1240 x 1240 pixels. Pediatric wide-field fundus photograph: 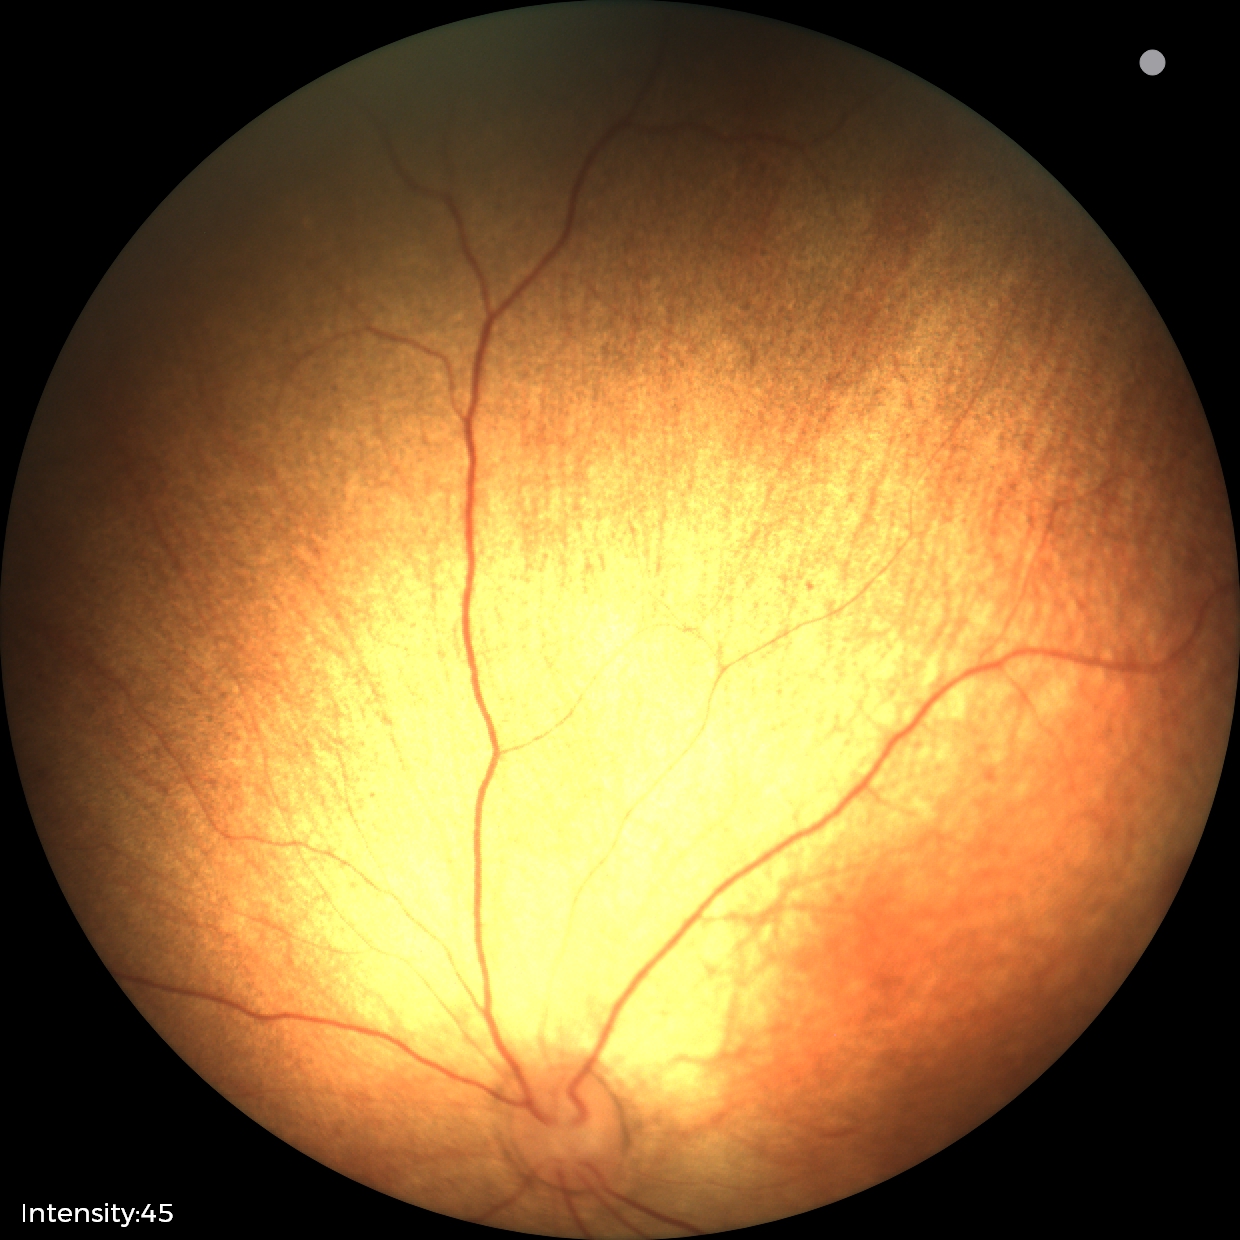

Screening examination diagnosed as physiological.